Infant wide-field fundus photograph · 1240 x 1240 pixels
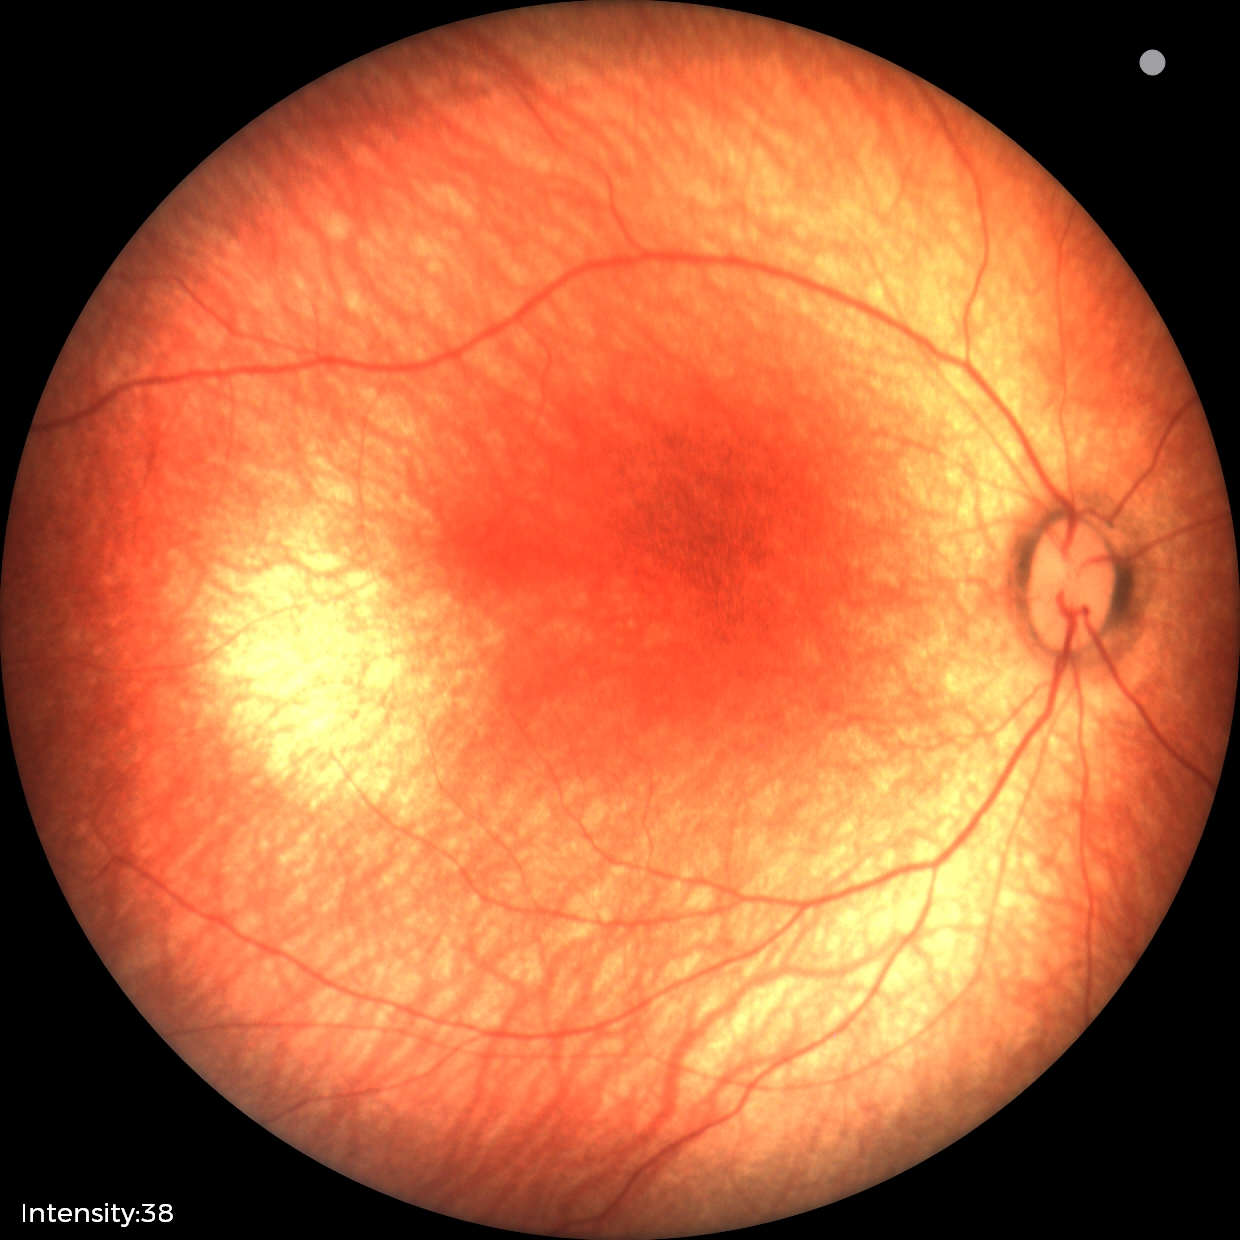
Screening examination diagnosed as physiological.